2102 by 1736 pixels; CFP
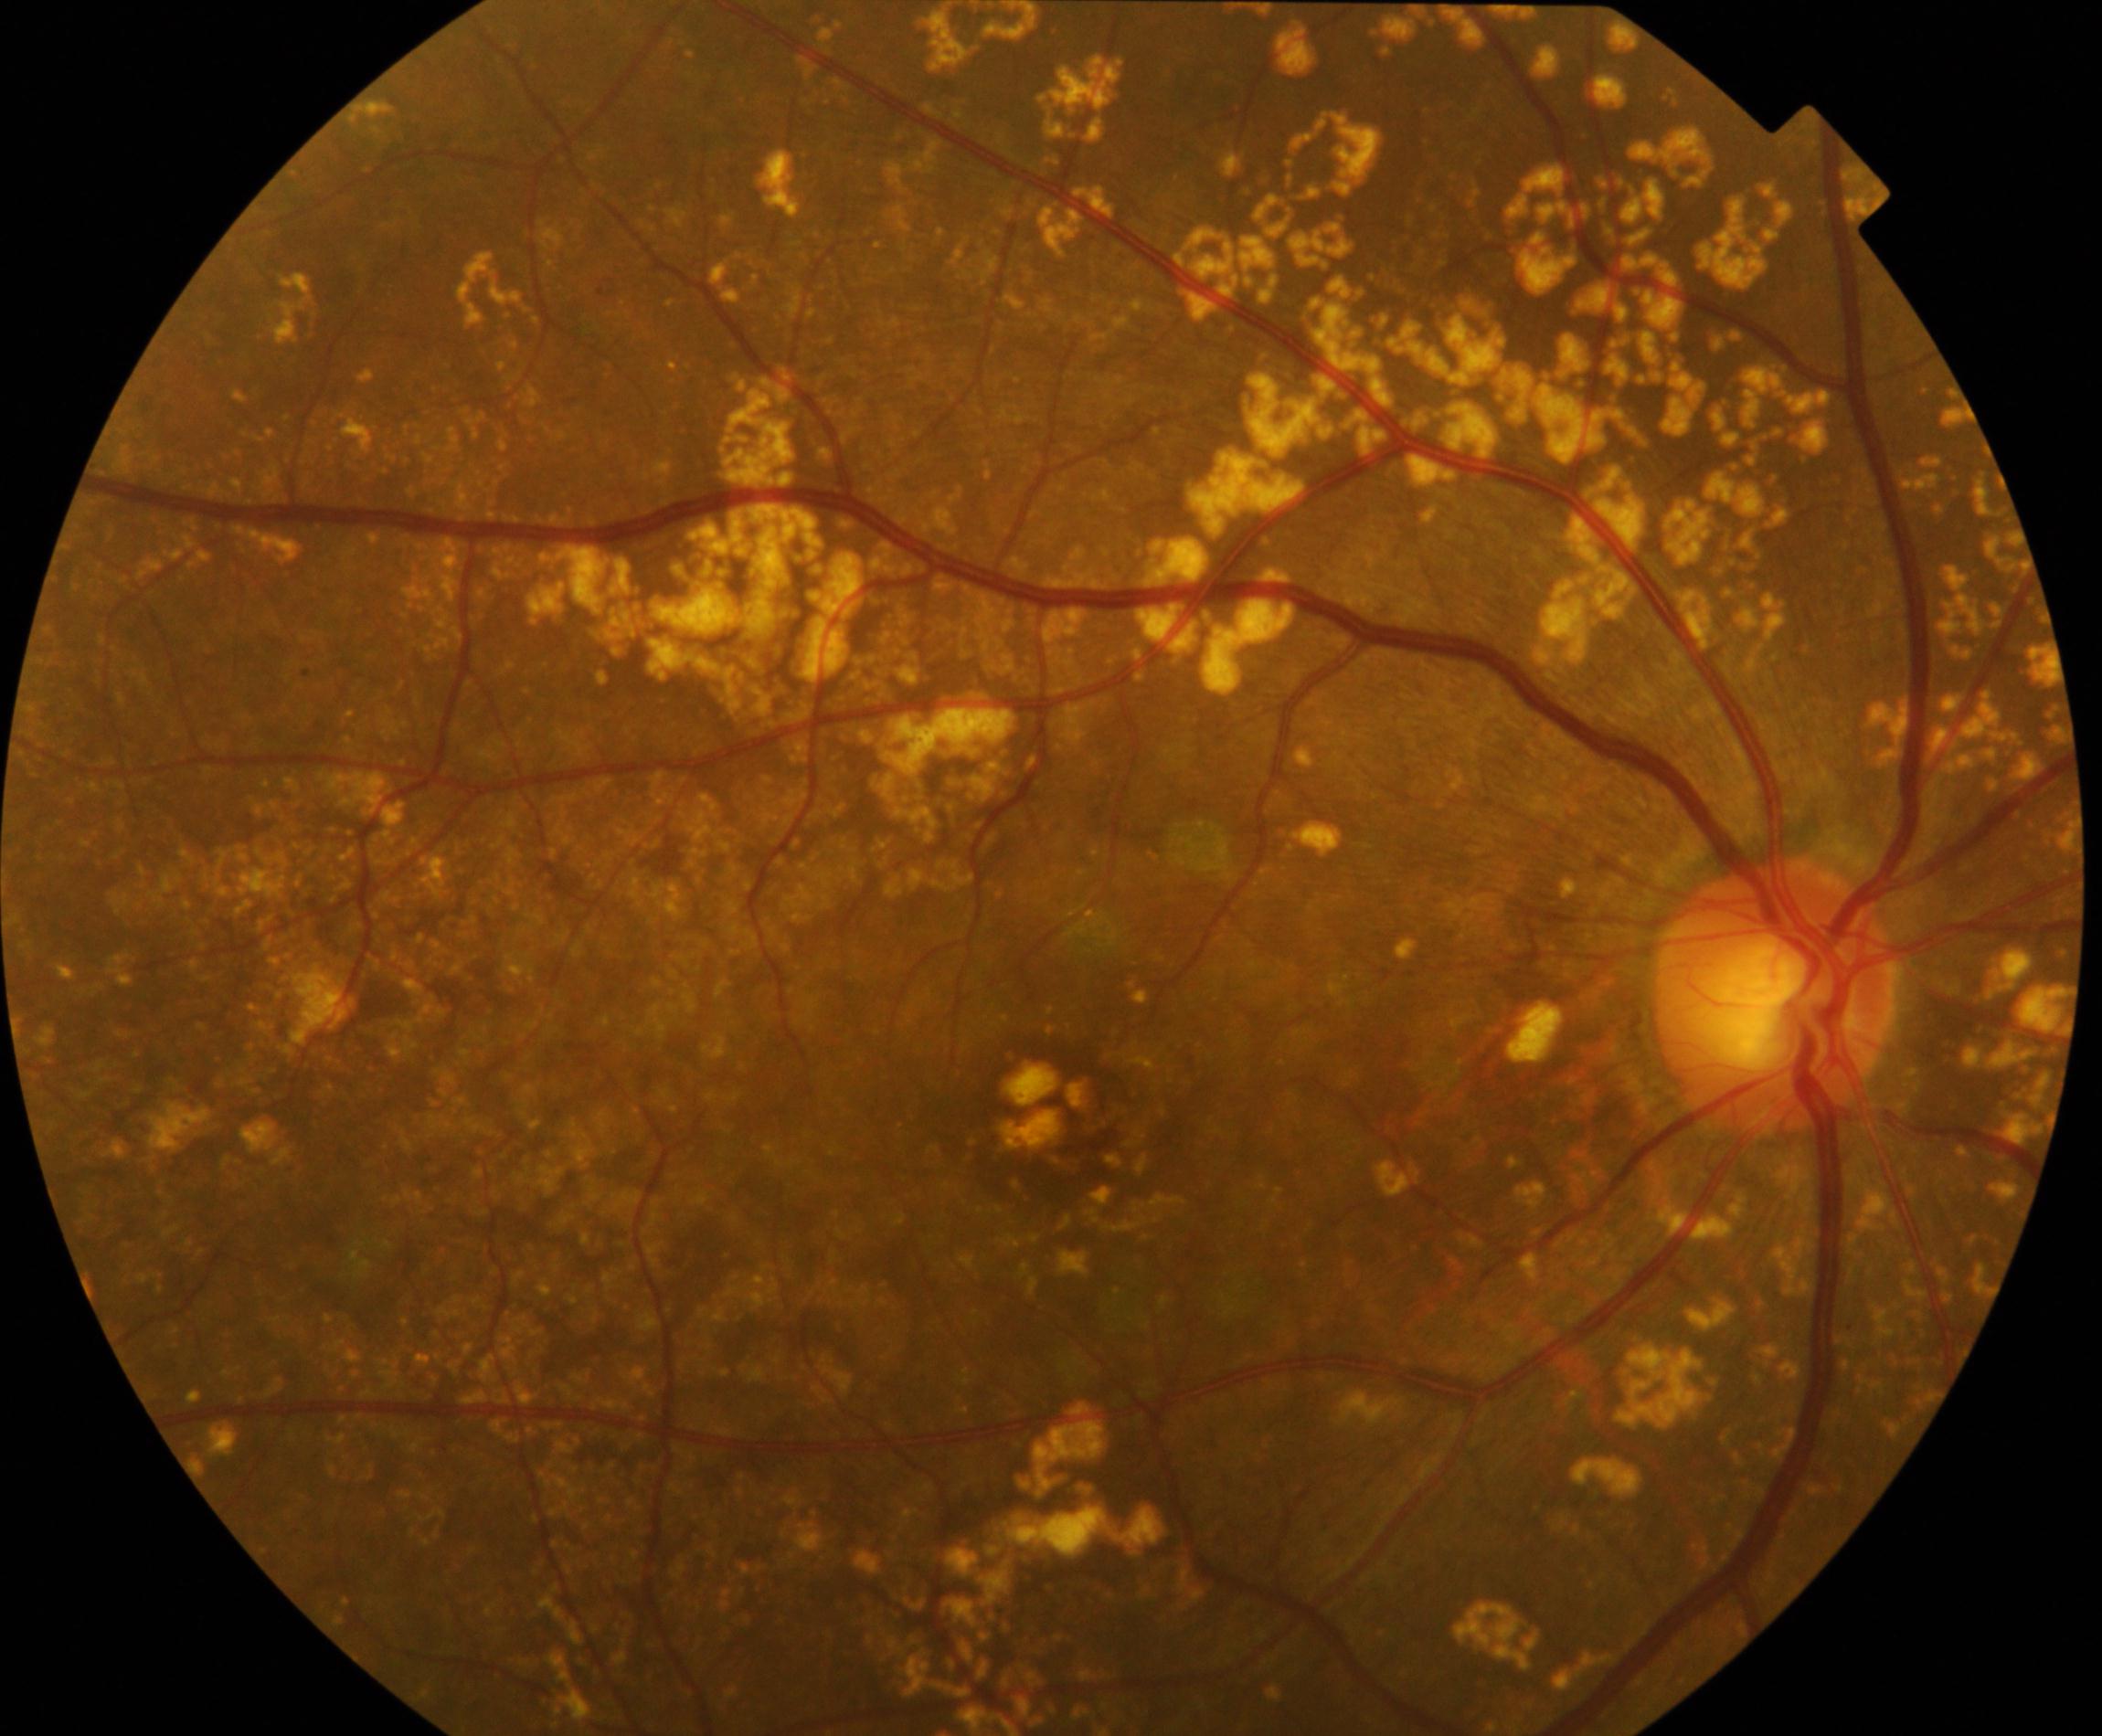
There is evidence of yellow-white spots or flecks.